Retinal fundus photograph. 45-degree field of view:
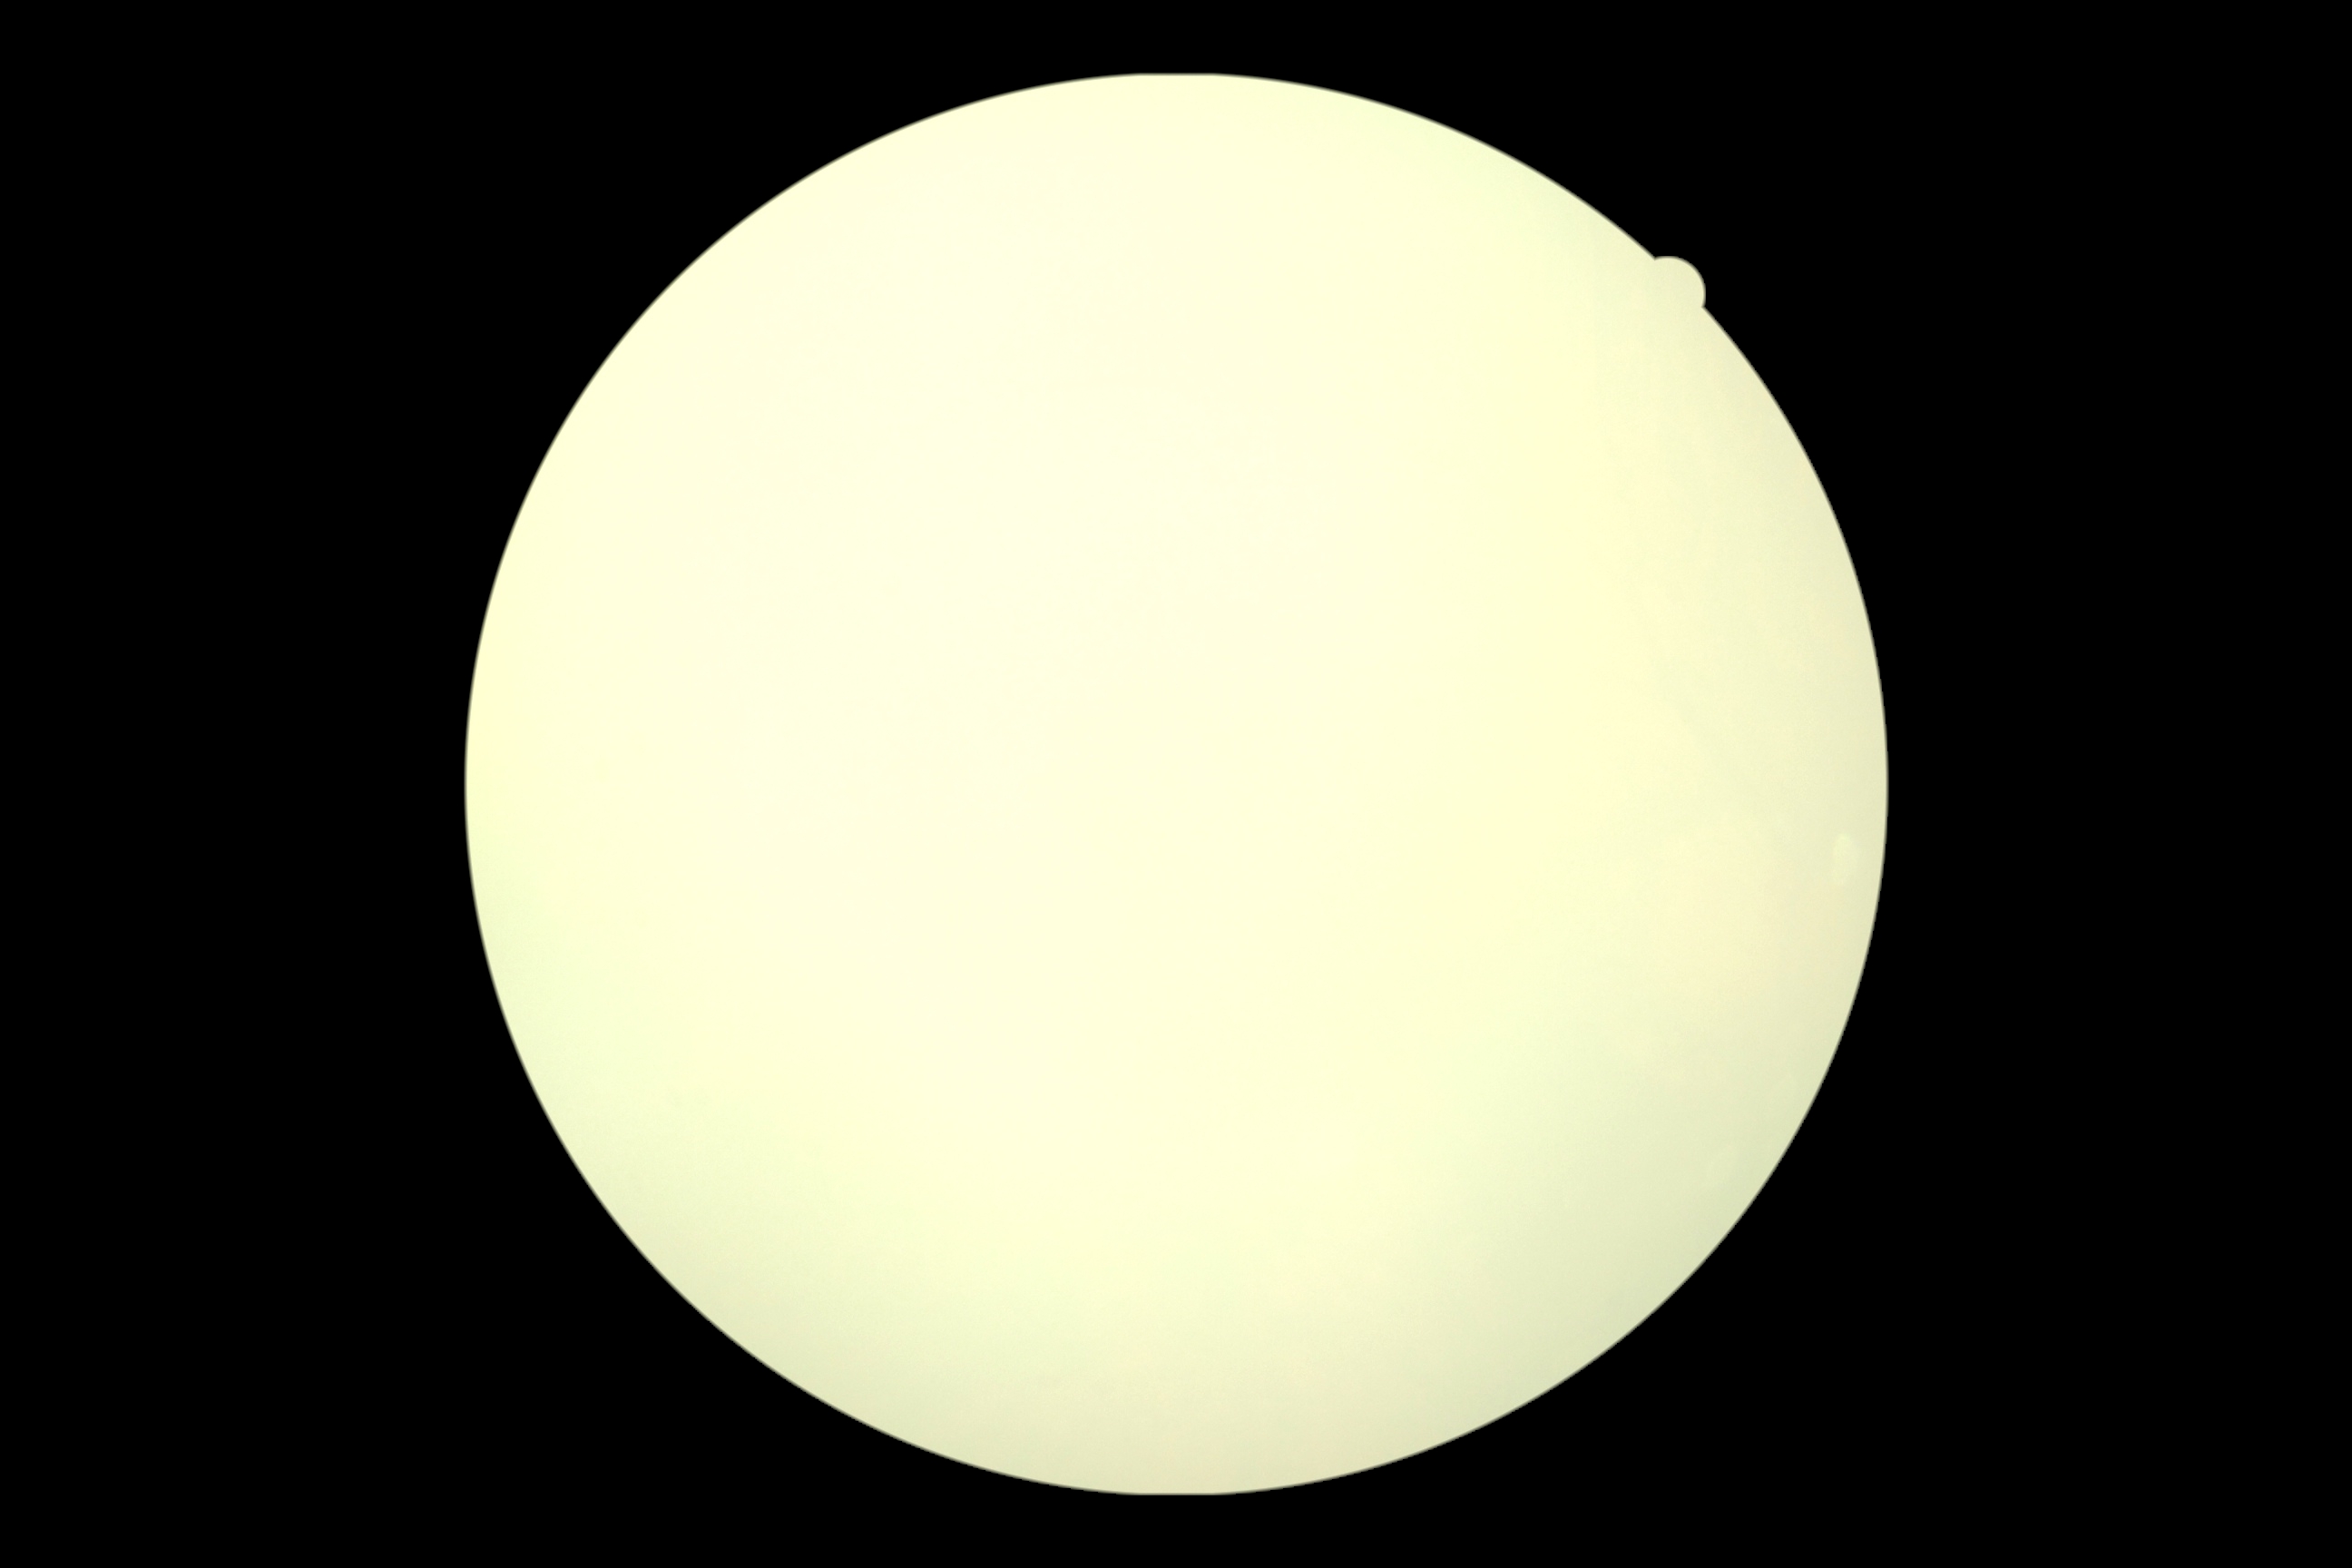
Diabetic retinopathy (DR) is ungradable.